Pediatric wide-field fundus photograph · image size 640x480
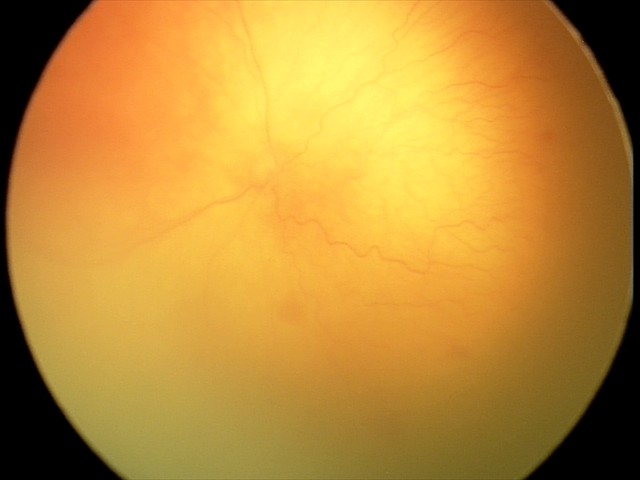
Screening series with A-ROP (aggressive ROP). Plus disease was diagnosed.